FOV: 45 degrees. Color fundus photograph. 2212 by 1659 pixels:
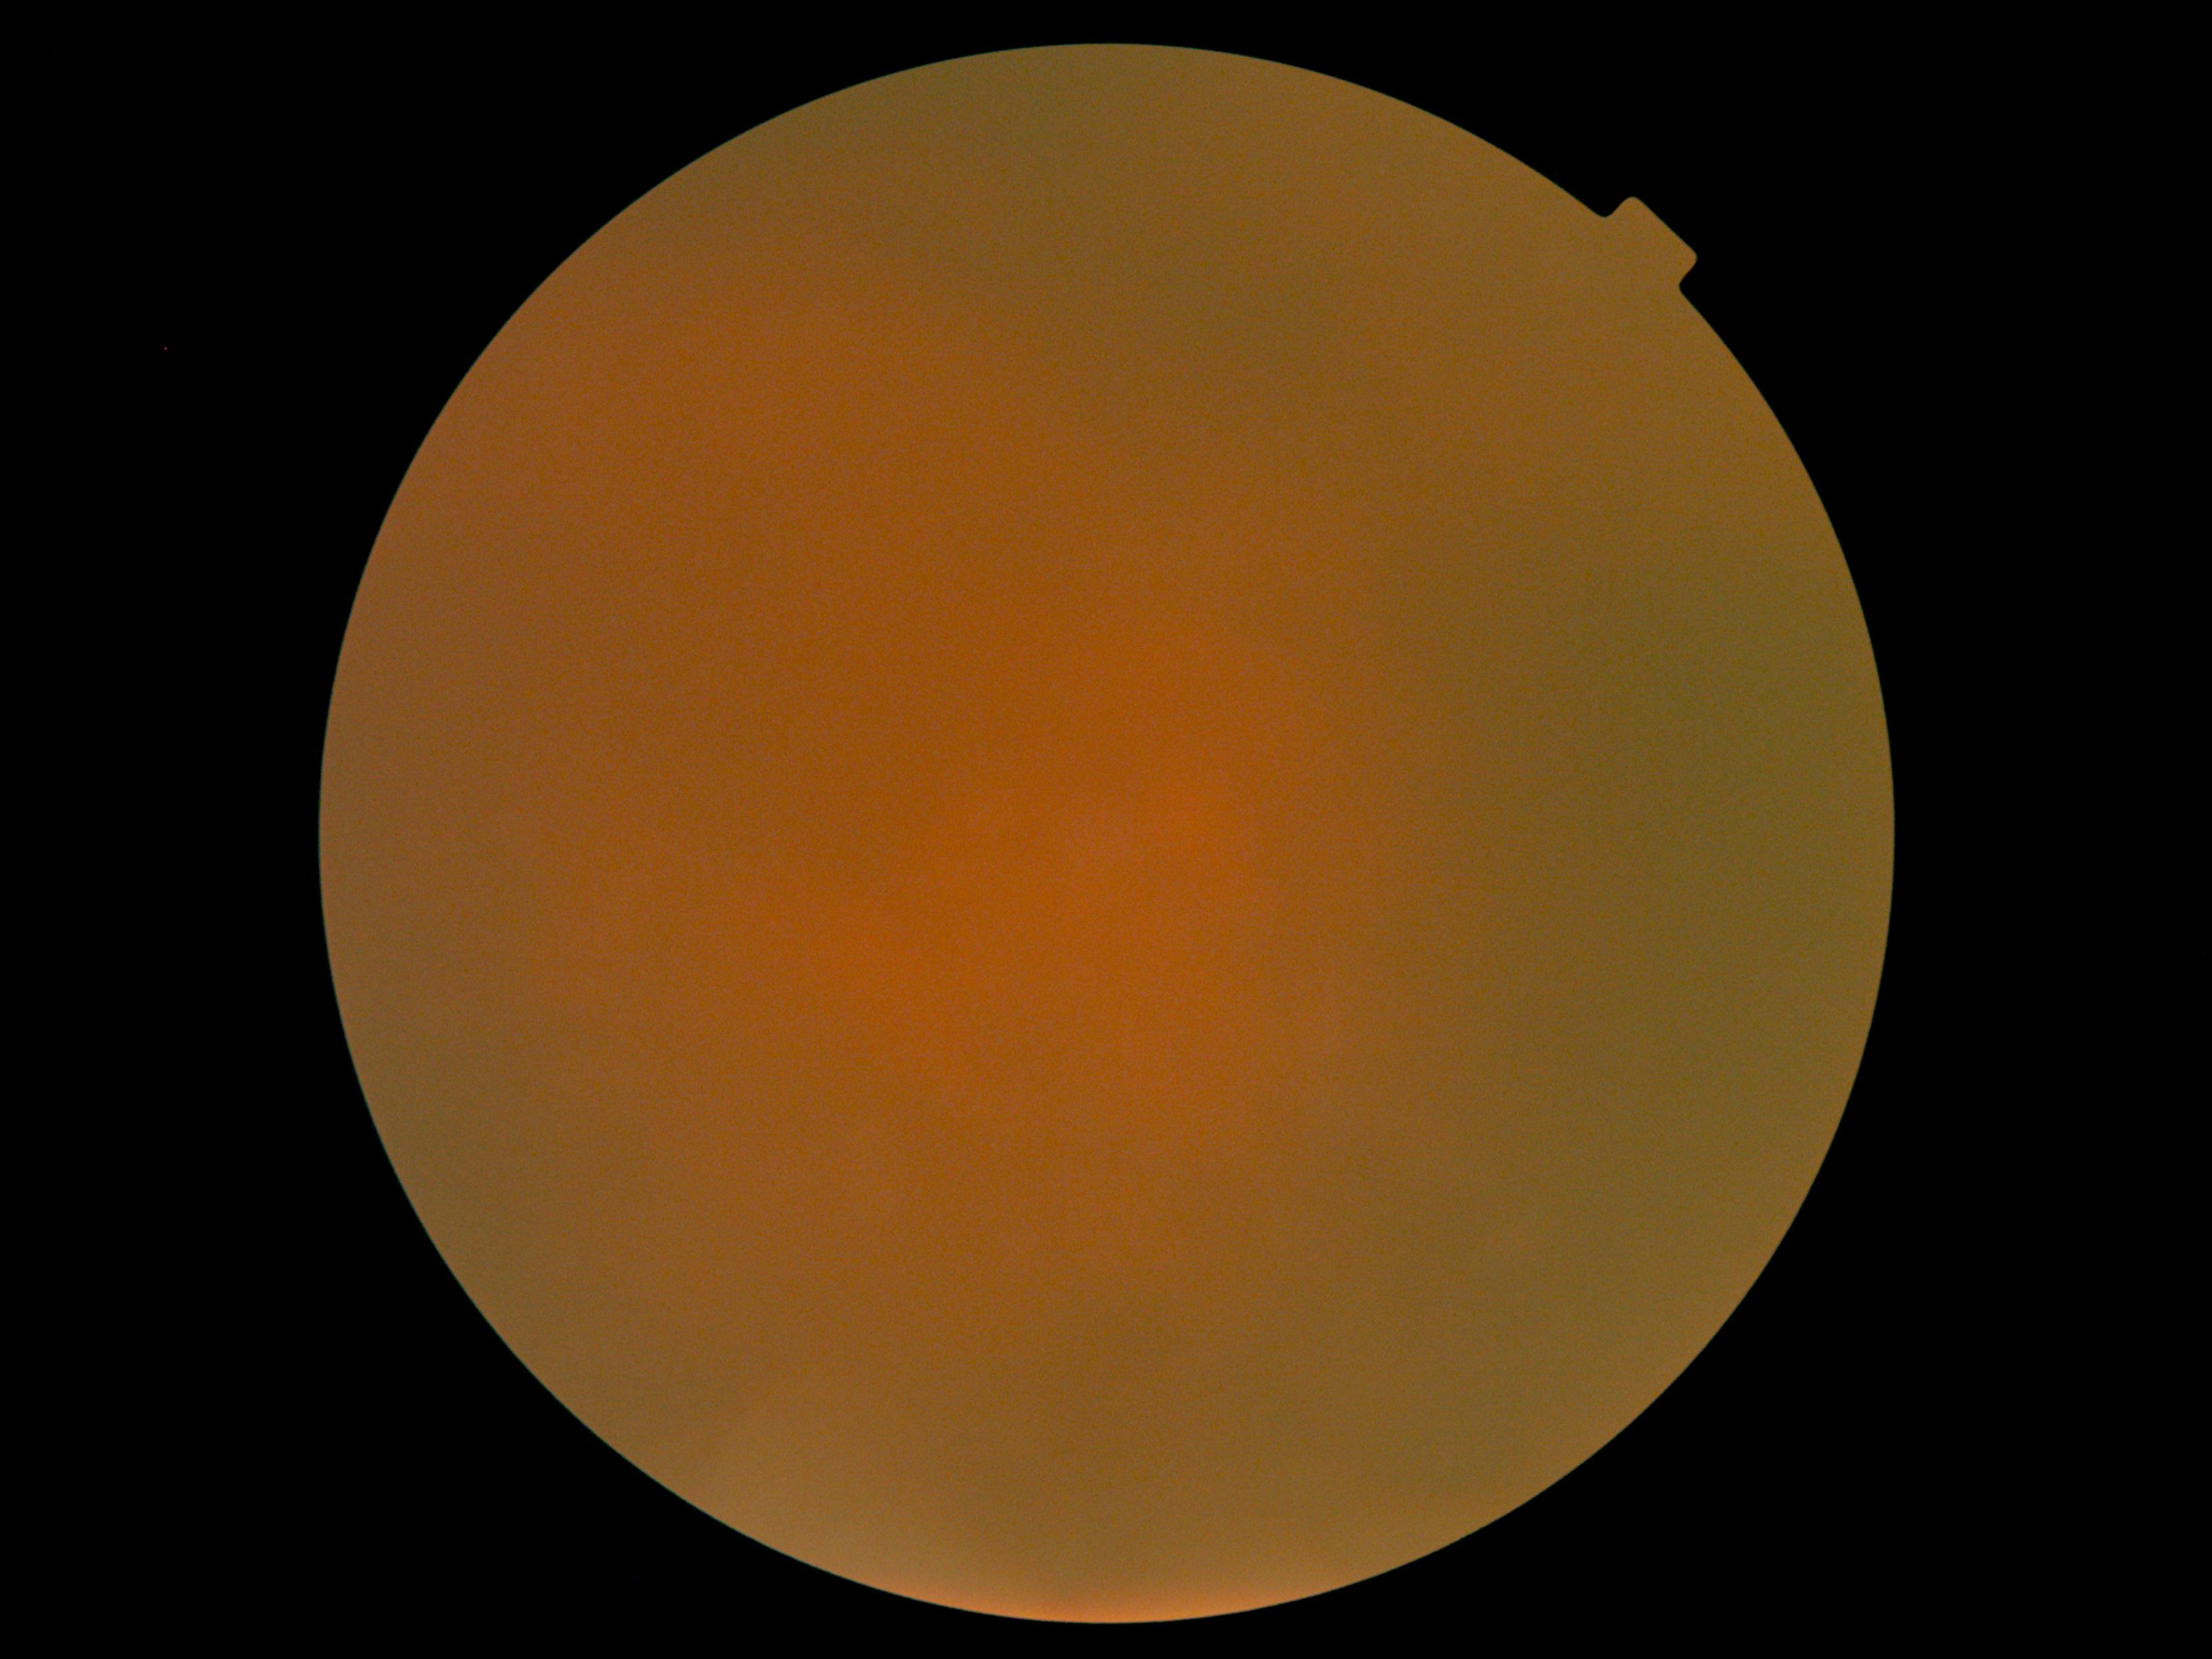

{
  "dr_grade": "ungradable"
}